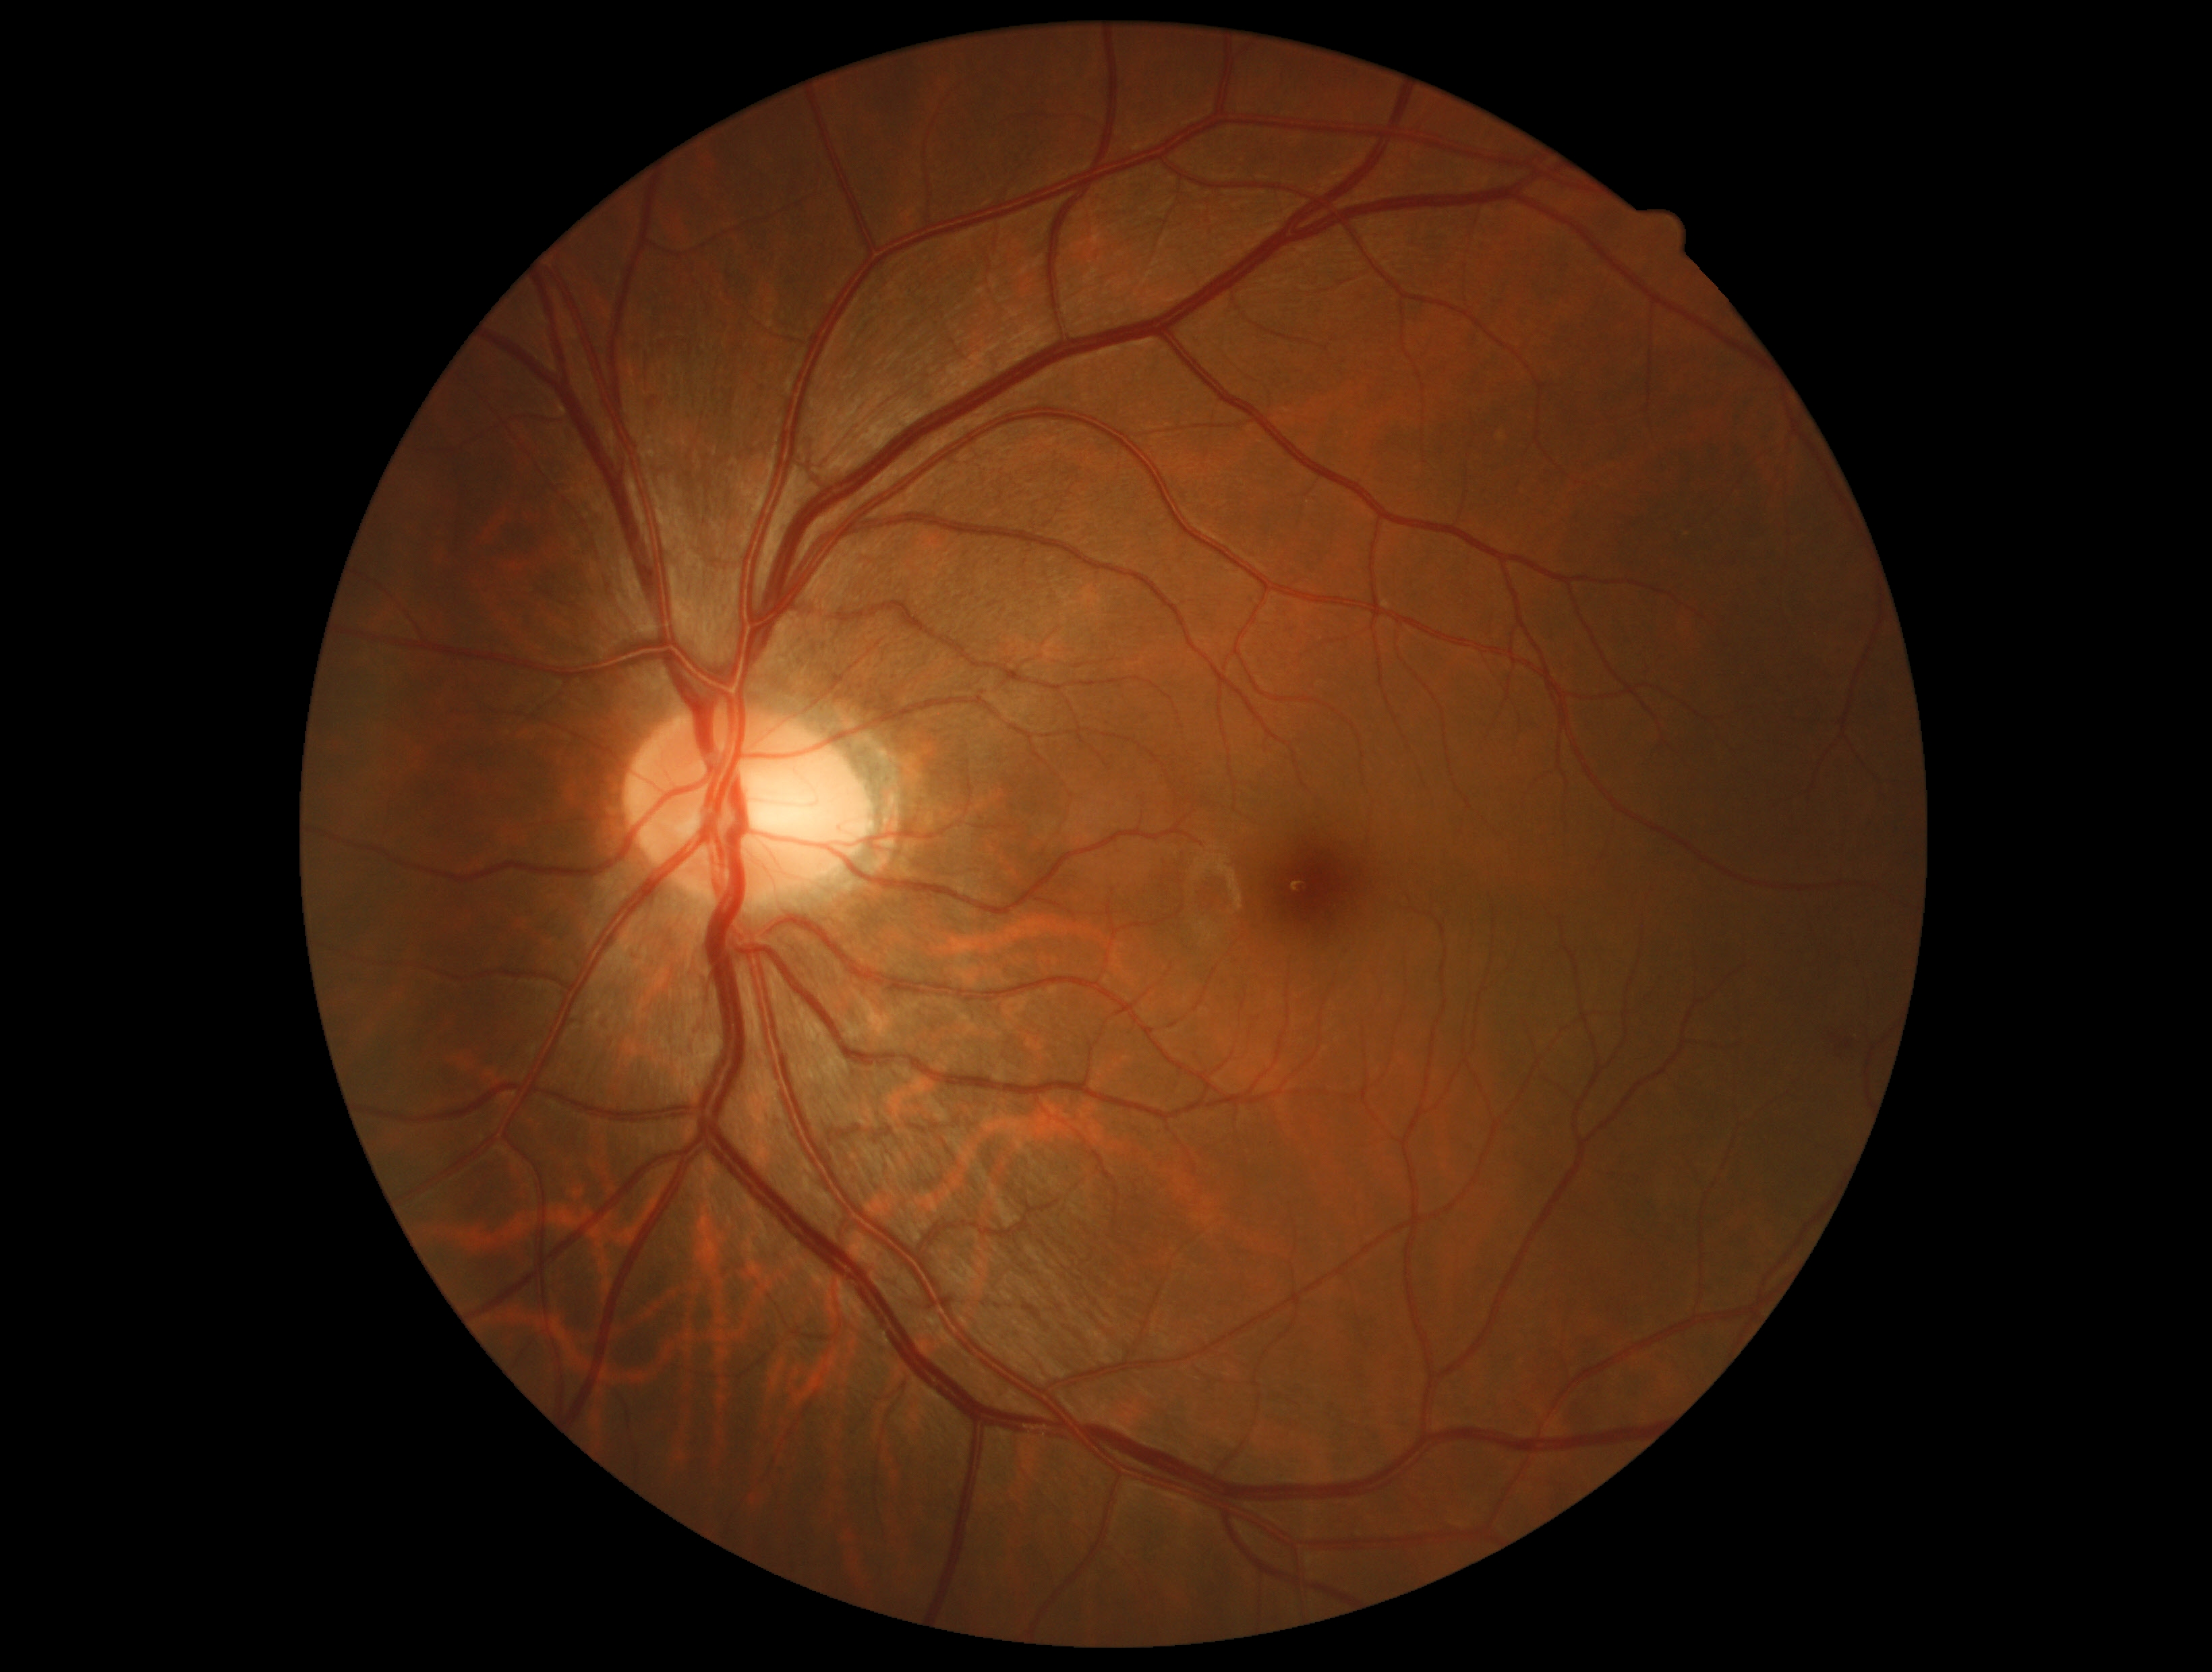

Diabetic retinopathy (DR): grade 2.